45° FOV:
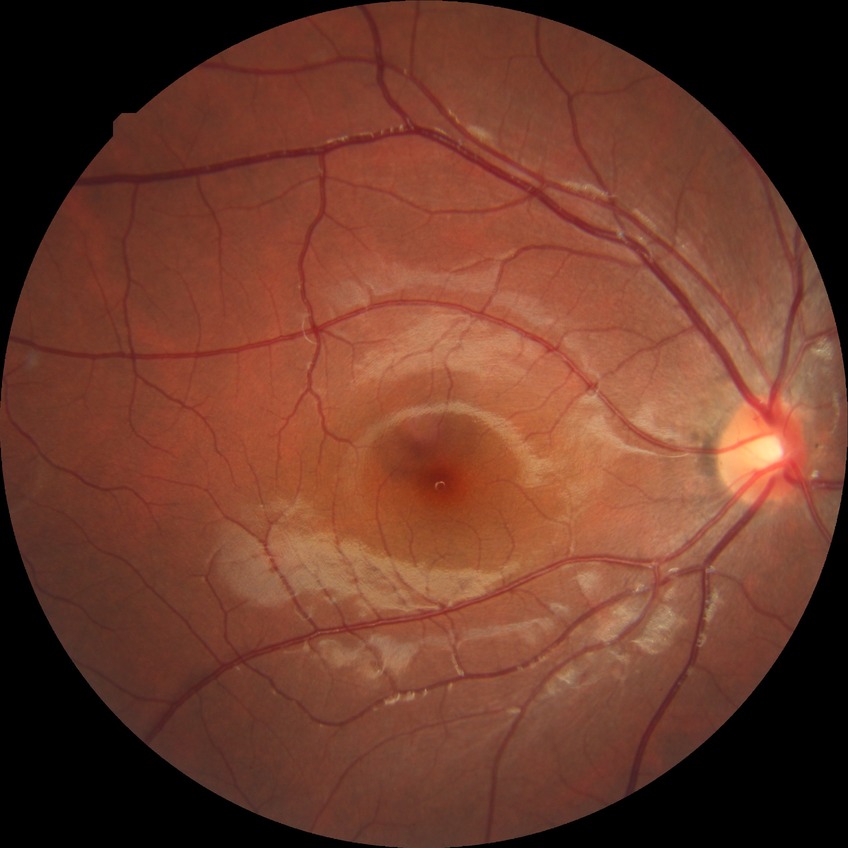 retinopathy grade=no diabetic retinopathy.